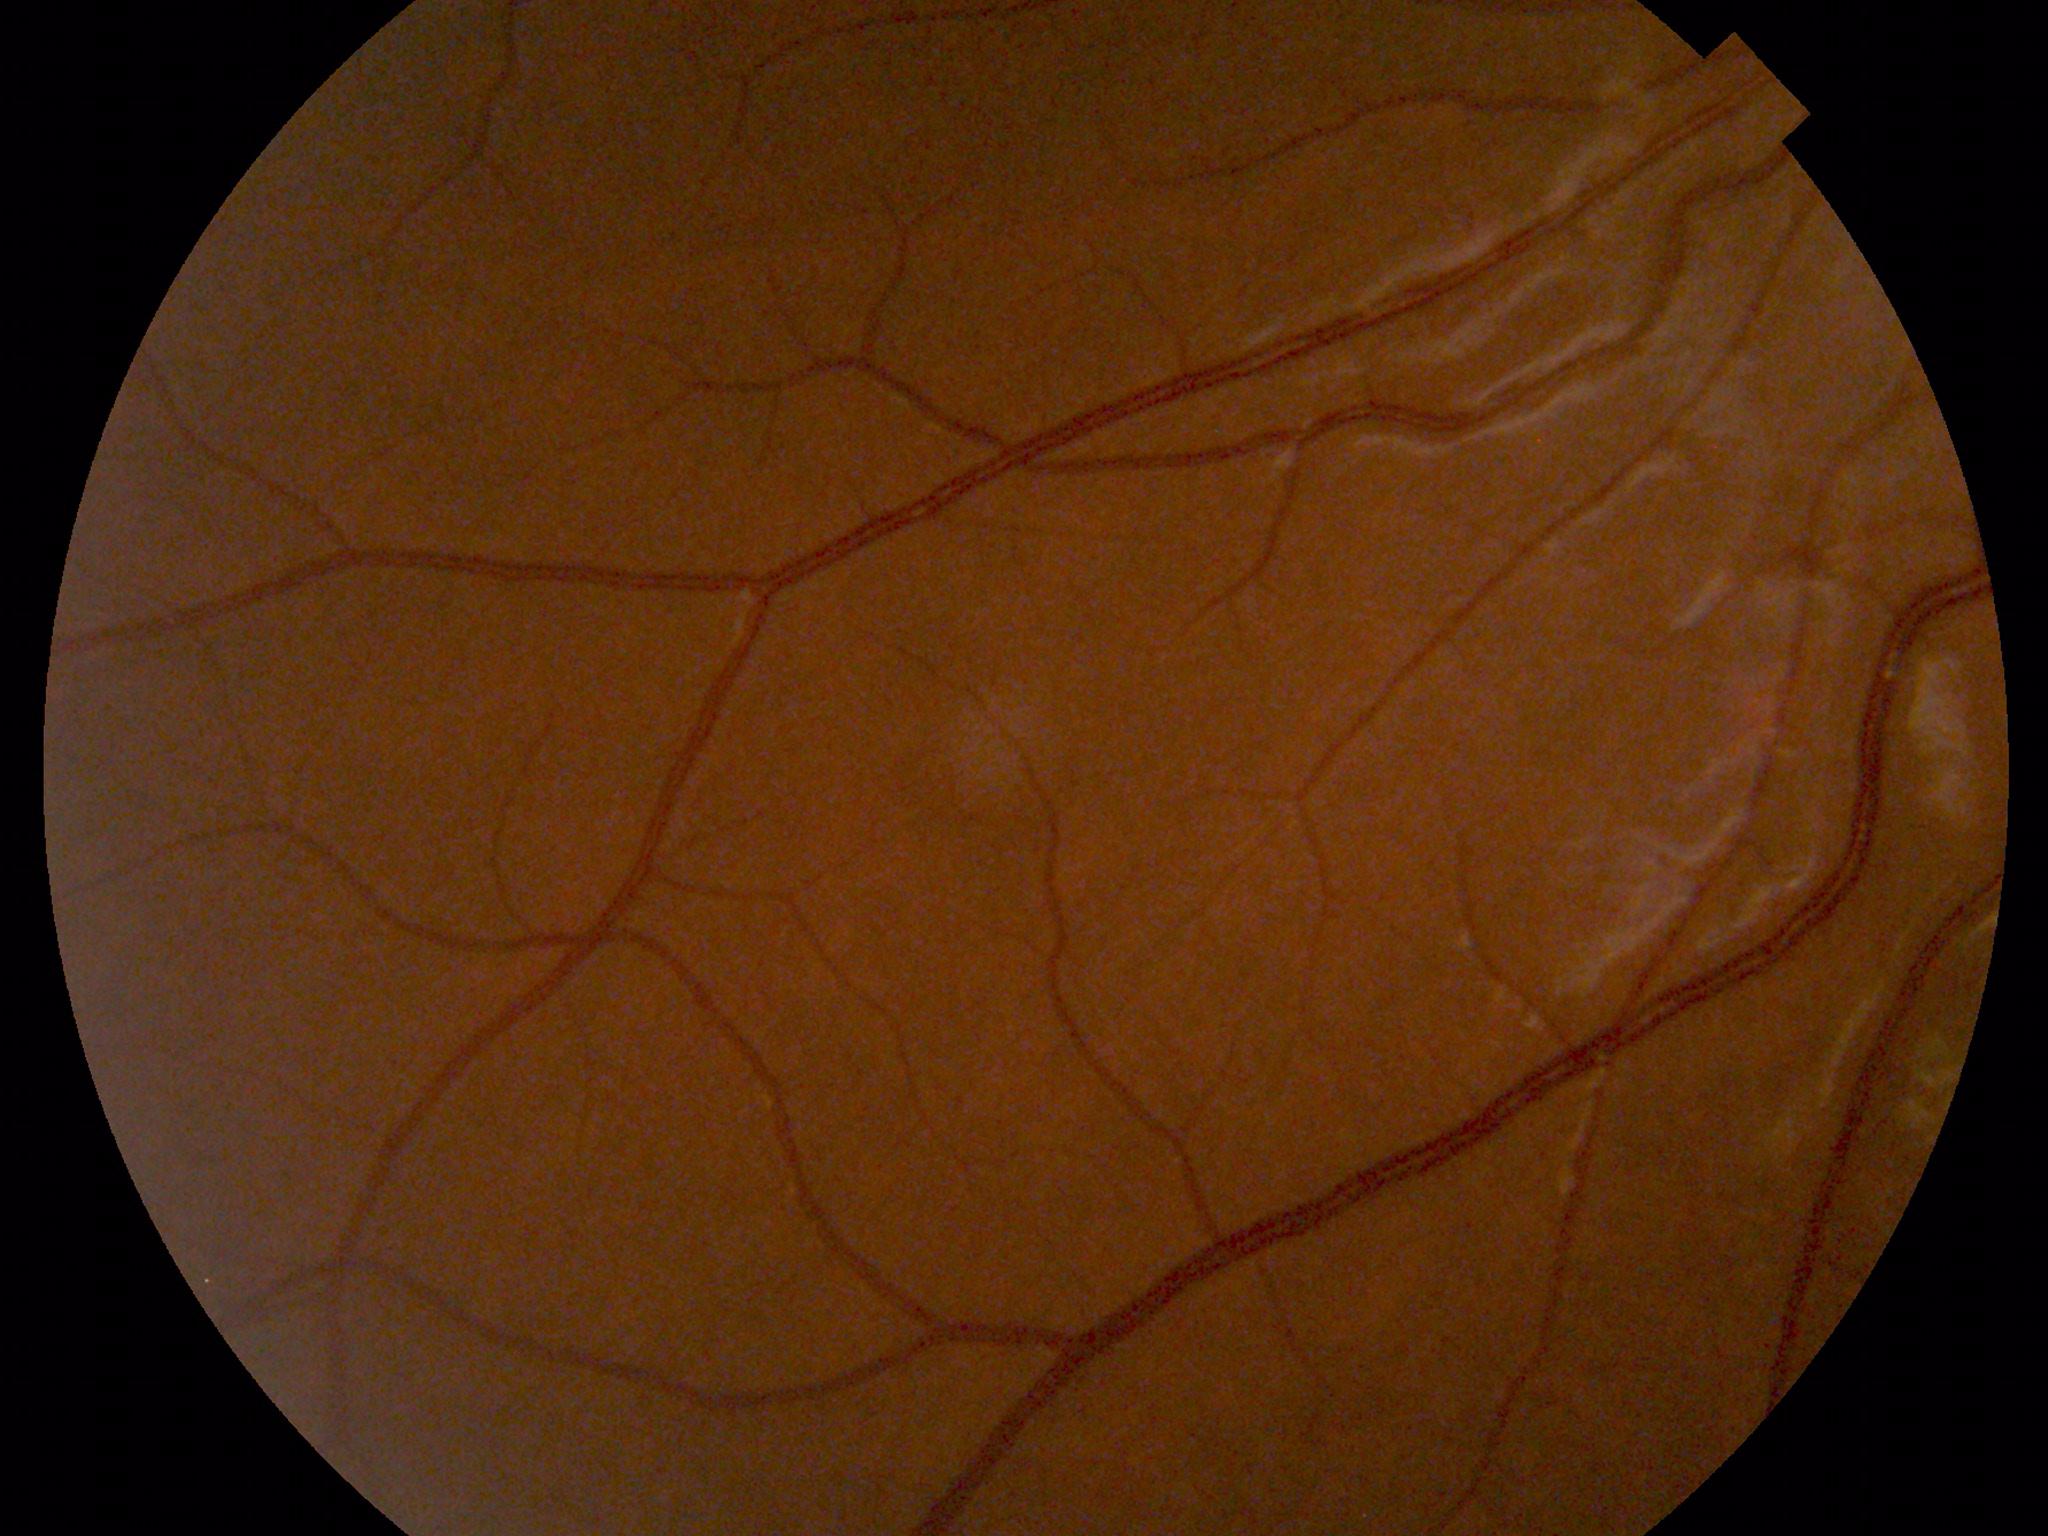

Findings: none. Normal fundus.